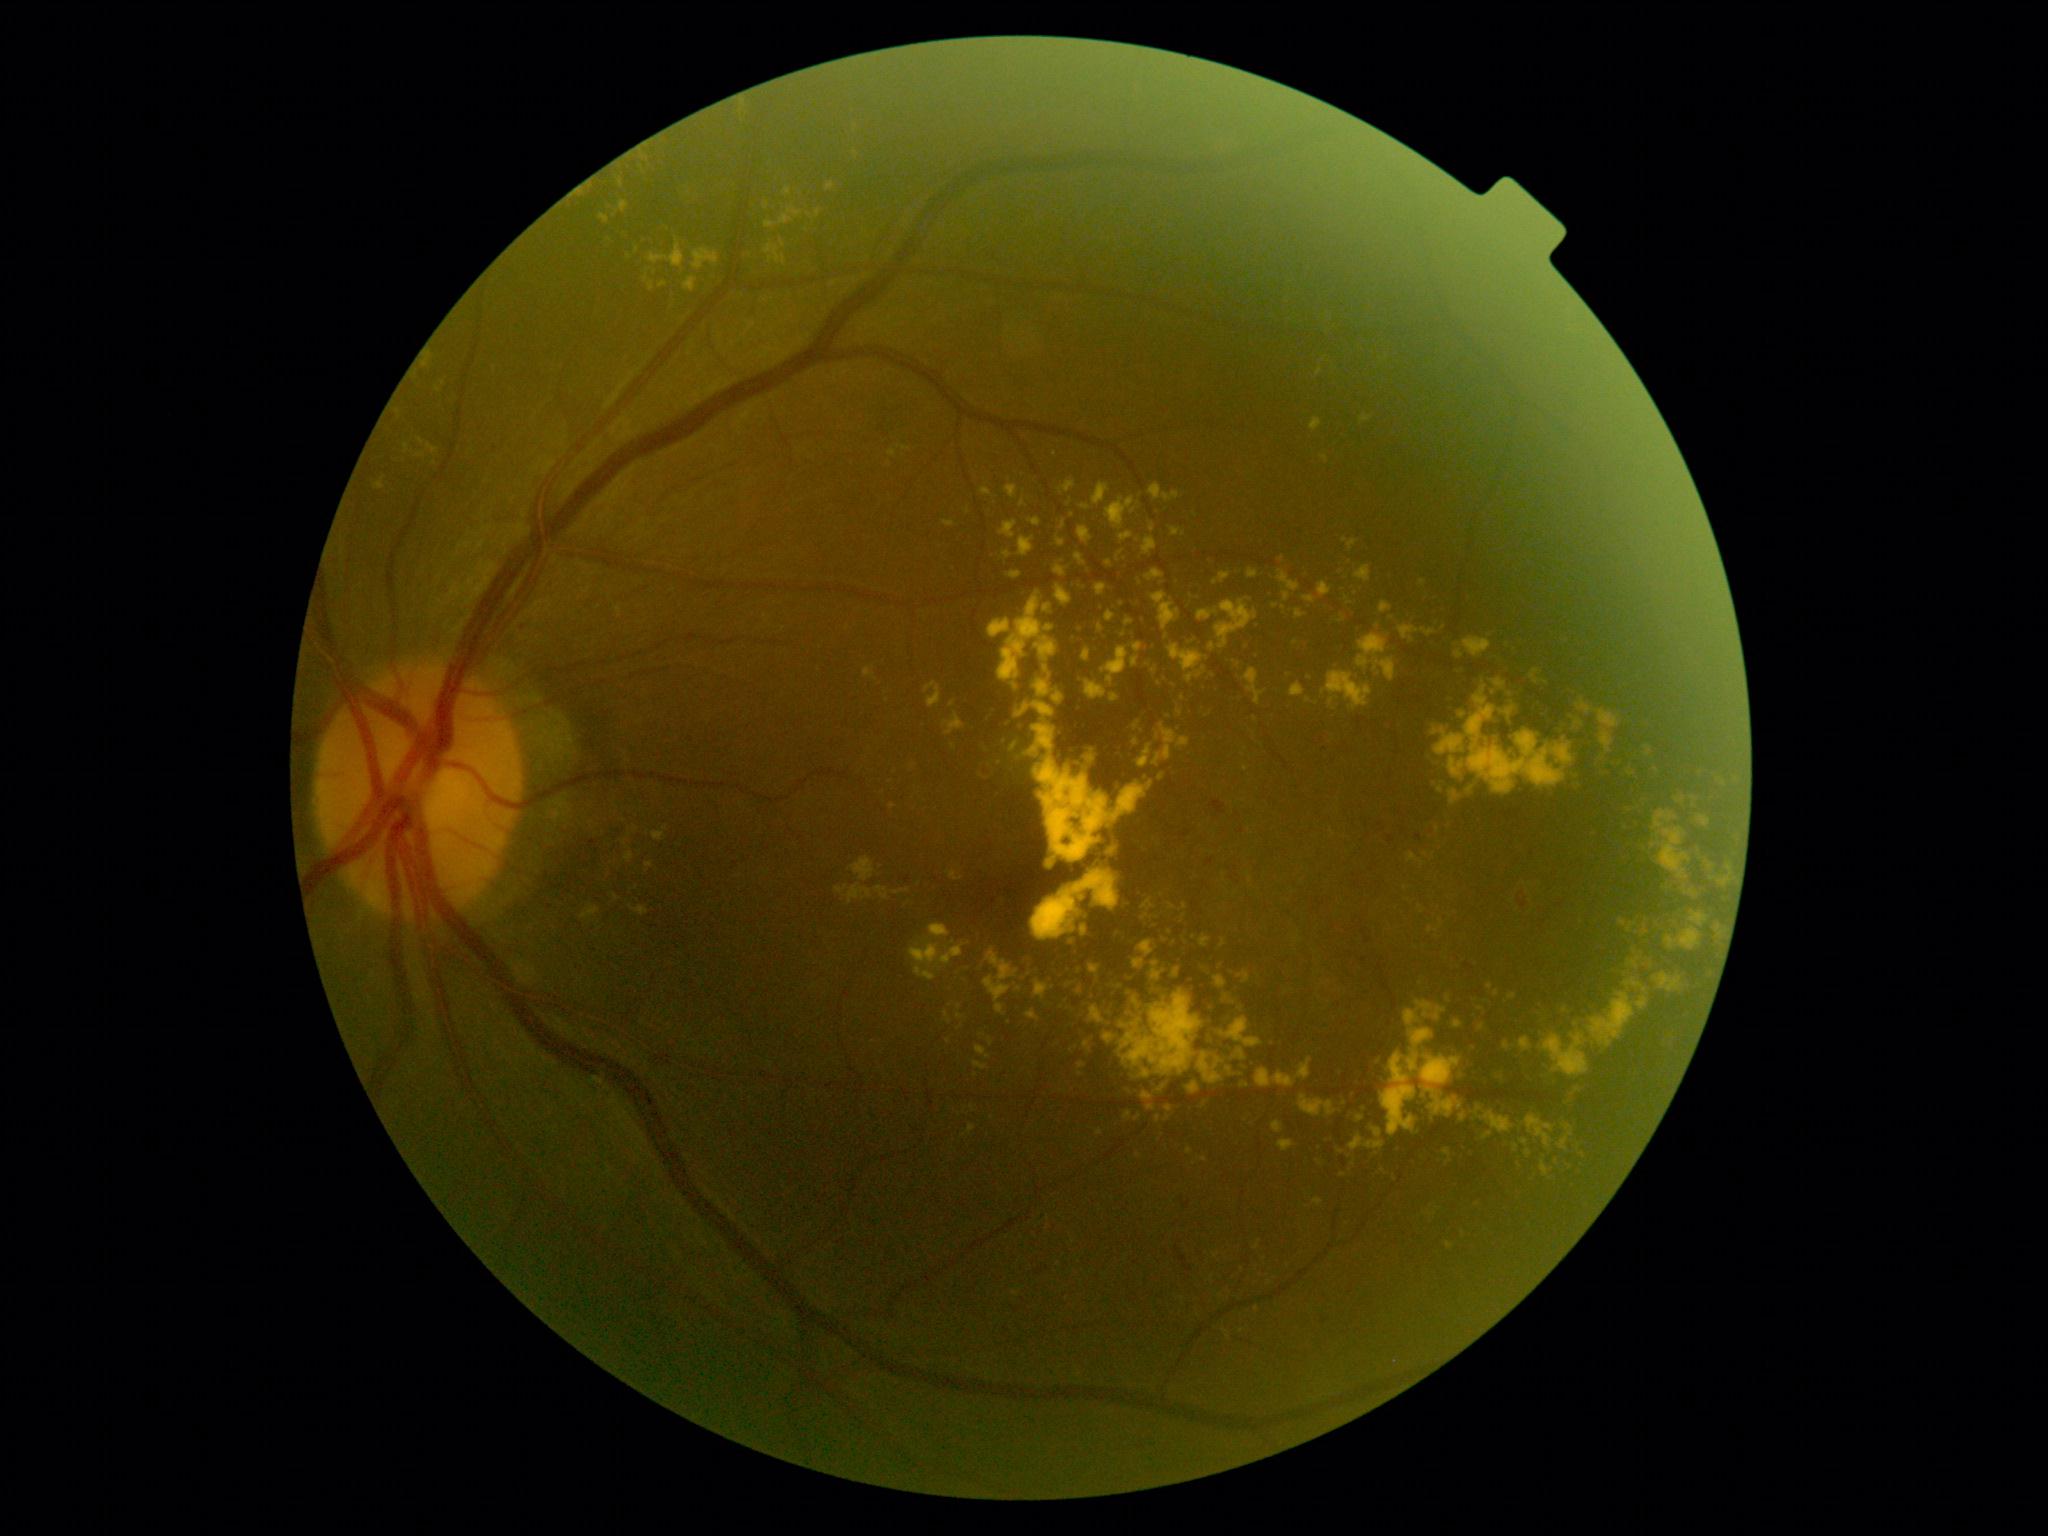

Findings:
* DR class — non-proliferative diabetic retinopathy
* diabetic retinopathy (DR) — grade 2 (moderate NPDR)